2212 by 1661 pixels. Gender: F. Autorefraction: +1 -1 x 95. Axial length 23.95 mm. Corneal thickness 605 µm. Intraocular pressure by pneumatic tonometry: 19 mmHg. Age 62: 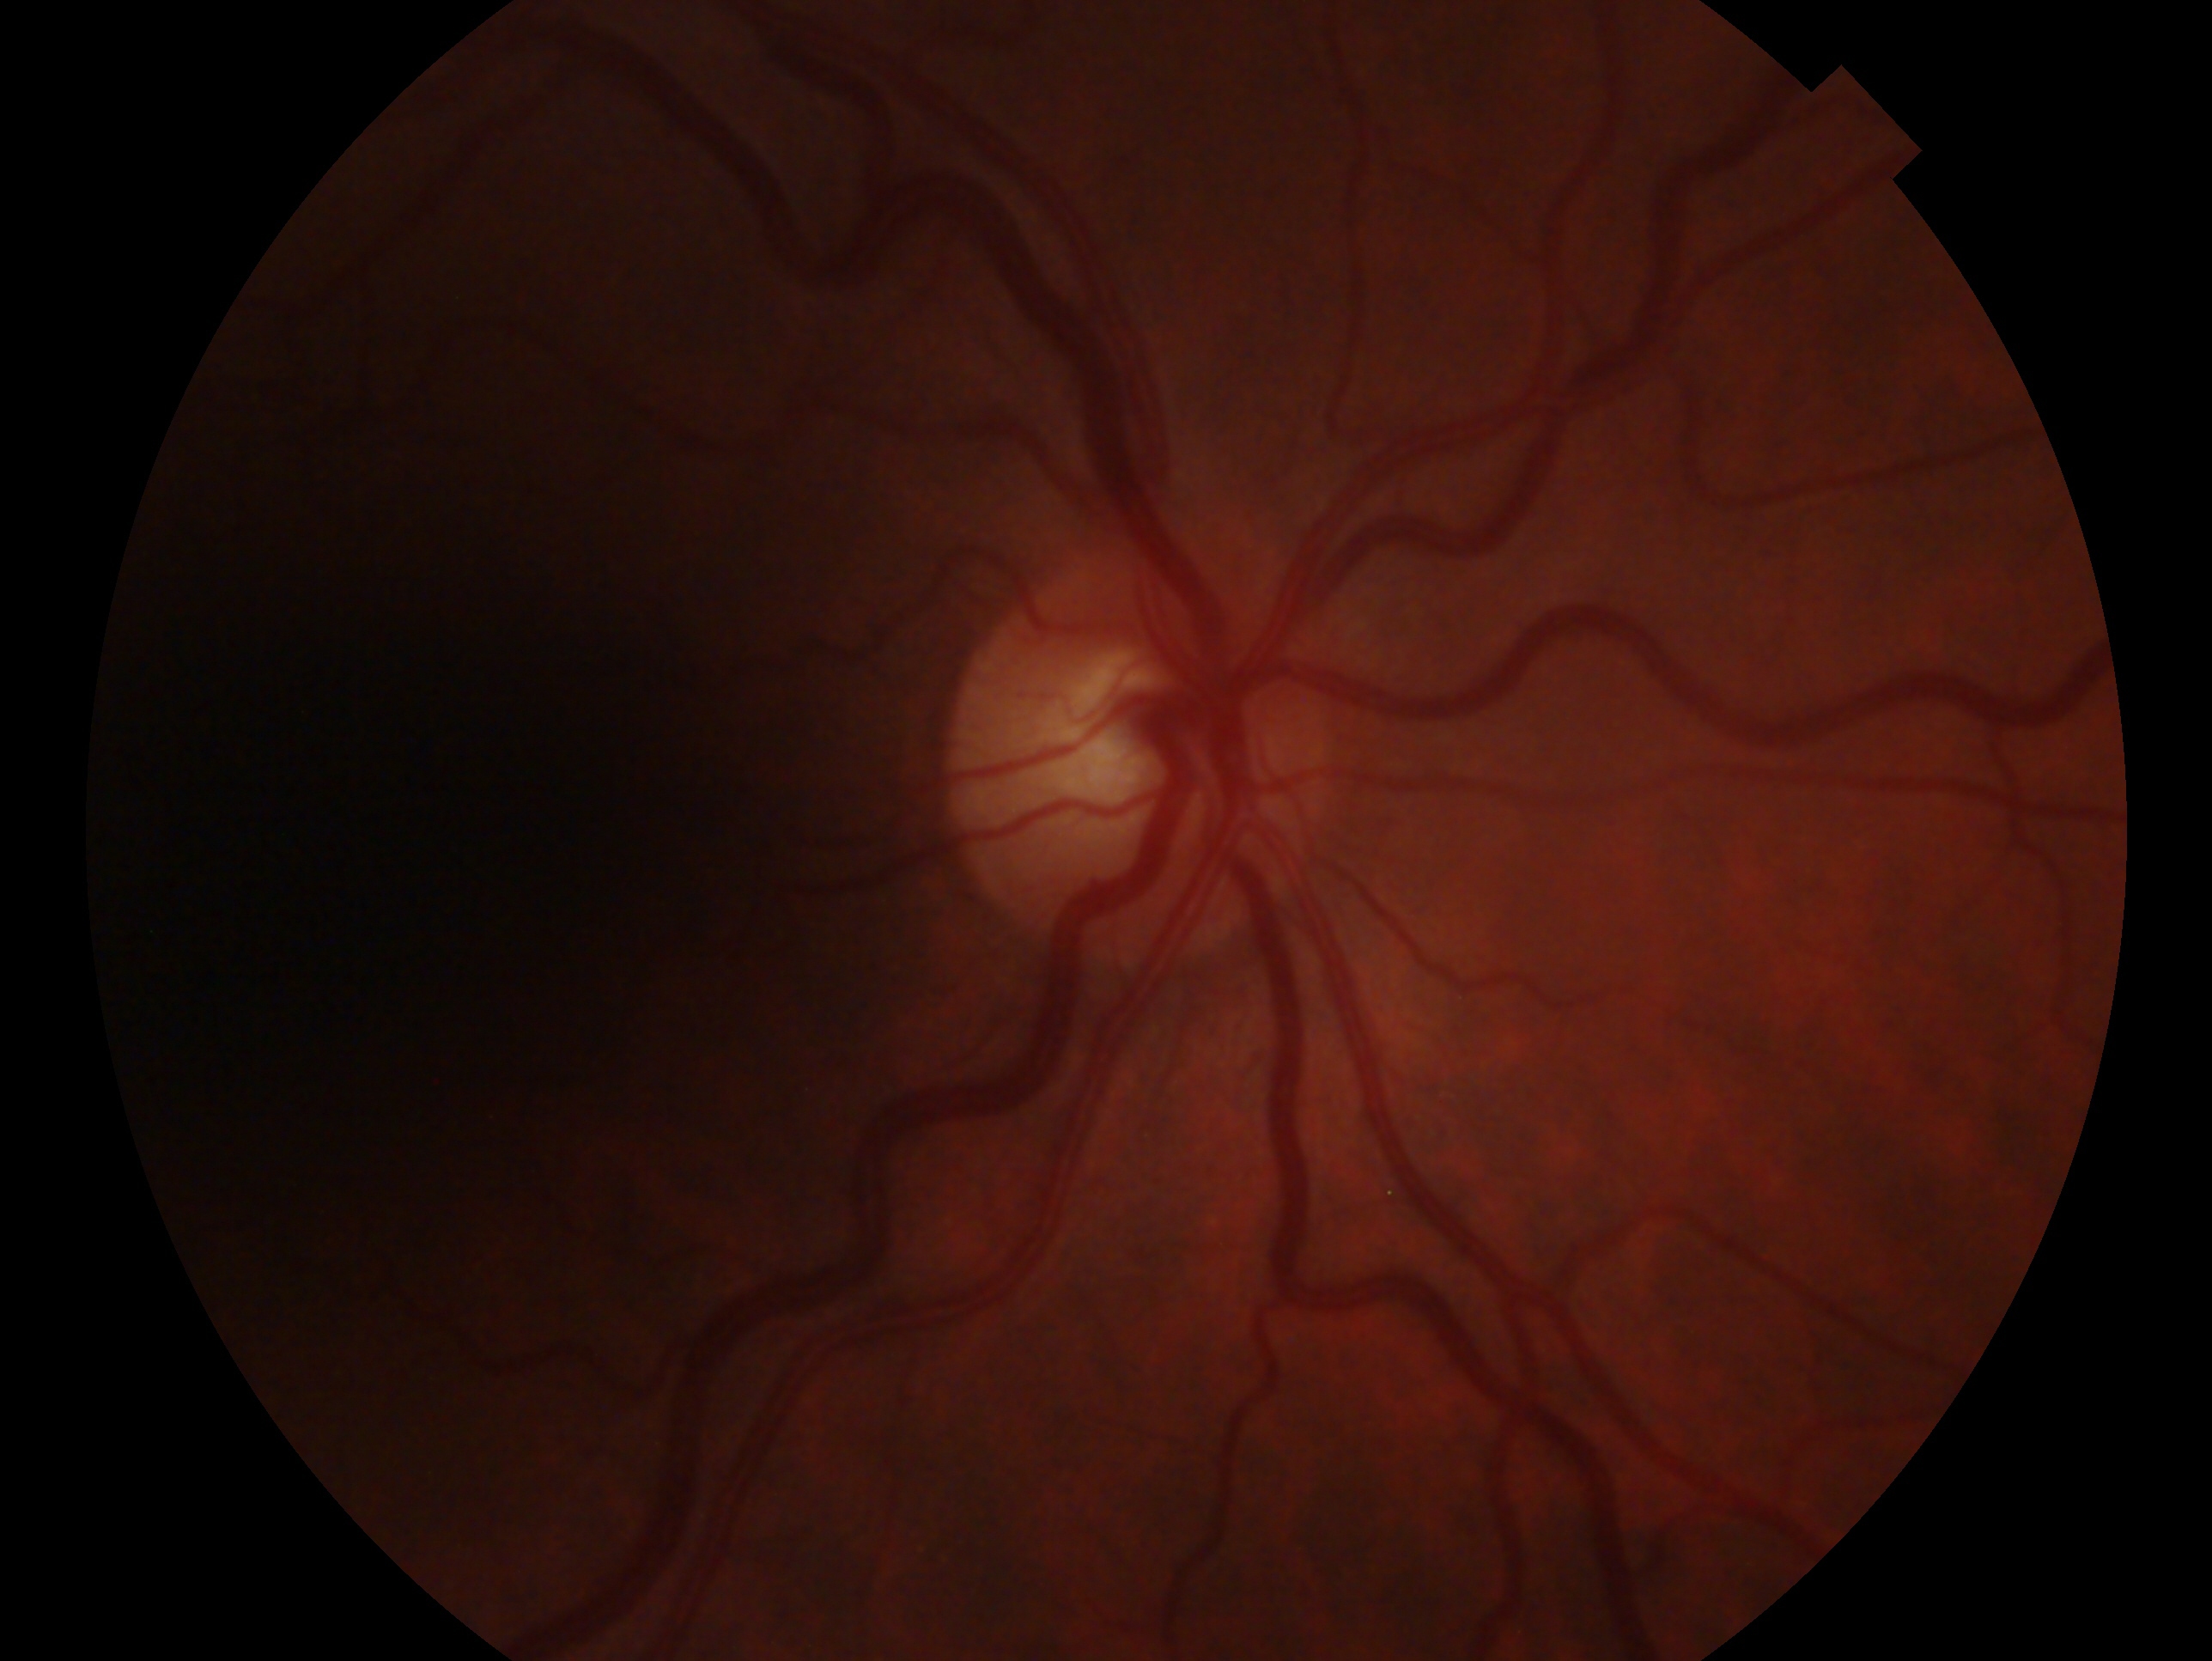
Imaged eye: right. Glaucoma diagnosis — no signs of glaucoma.